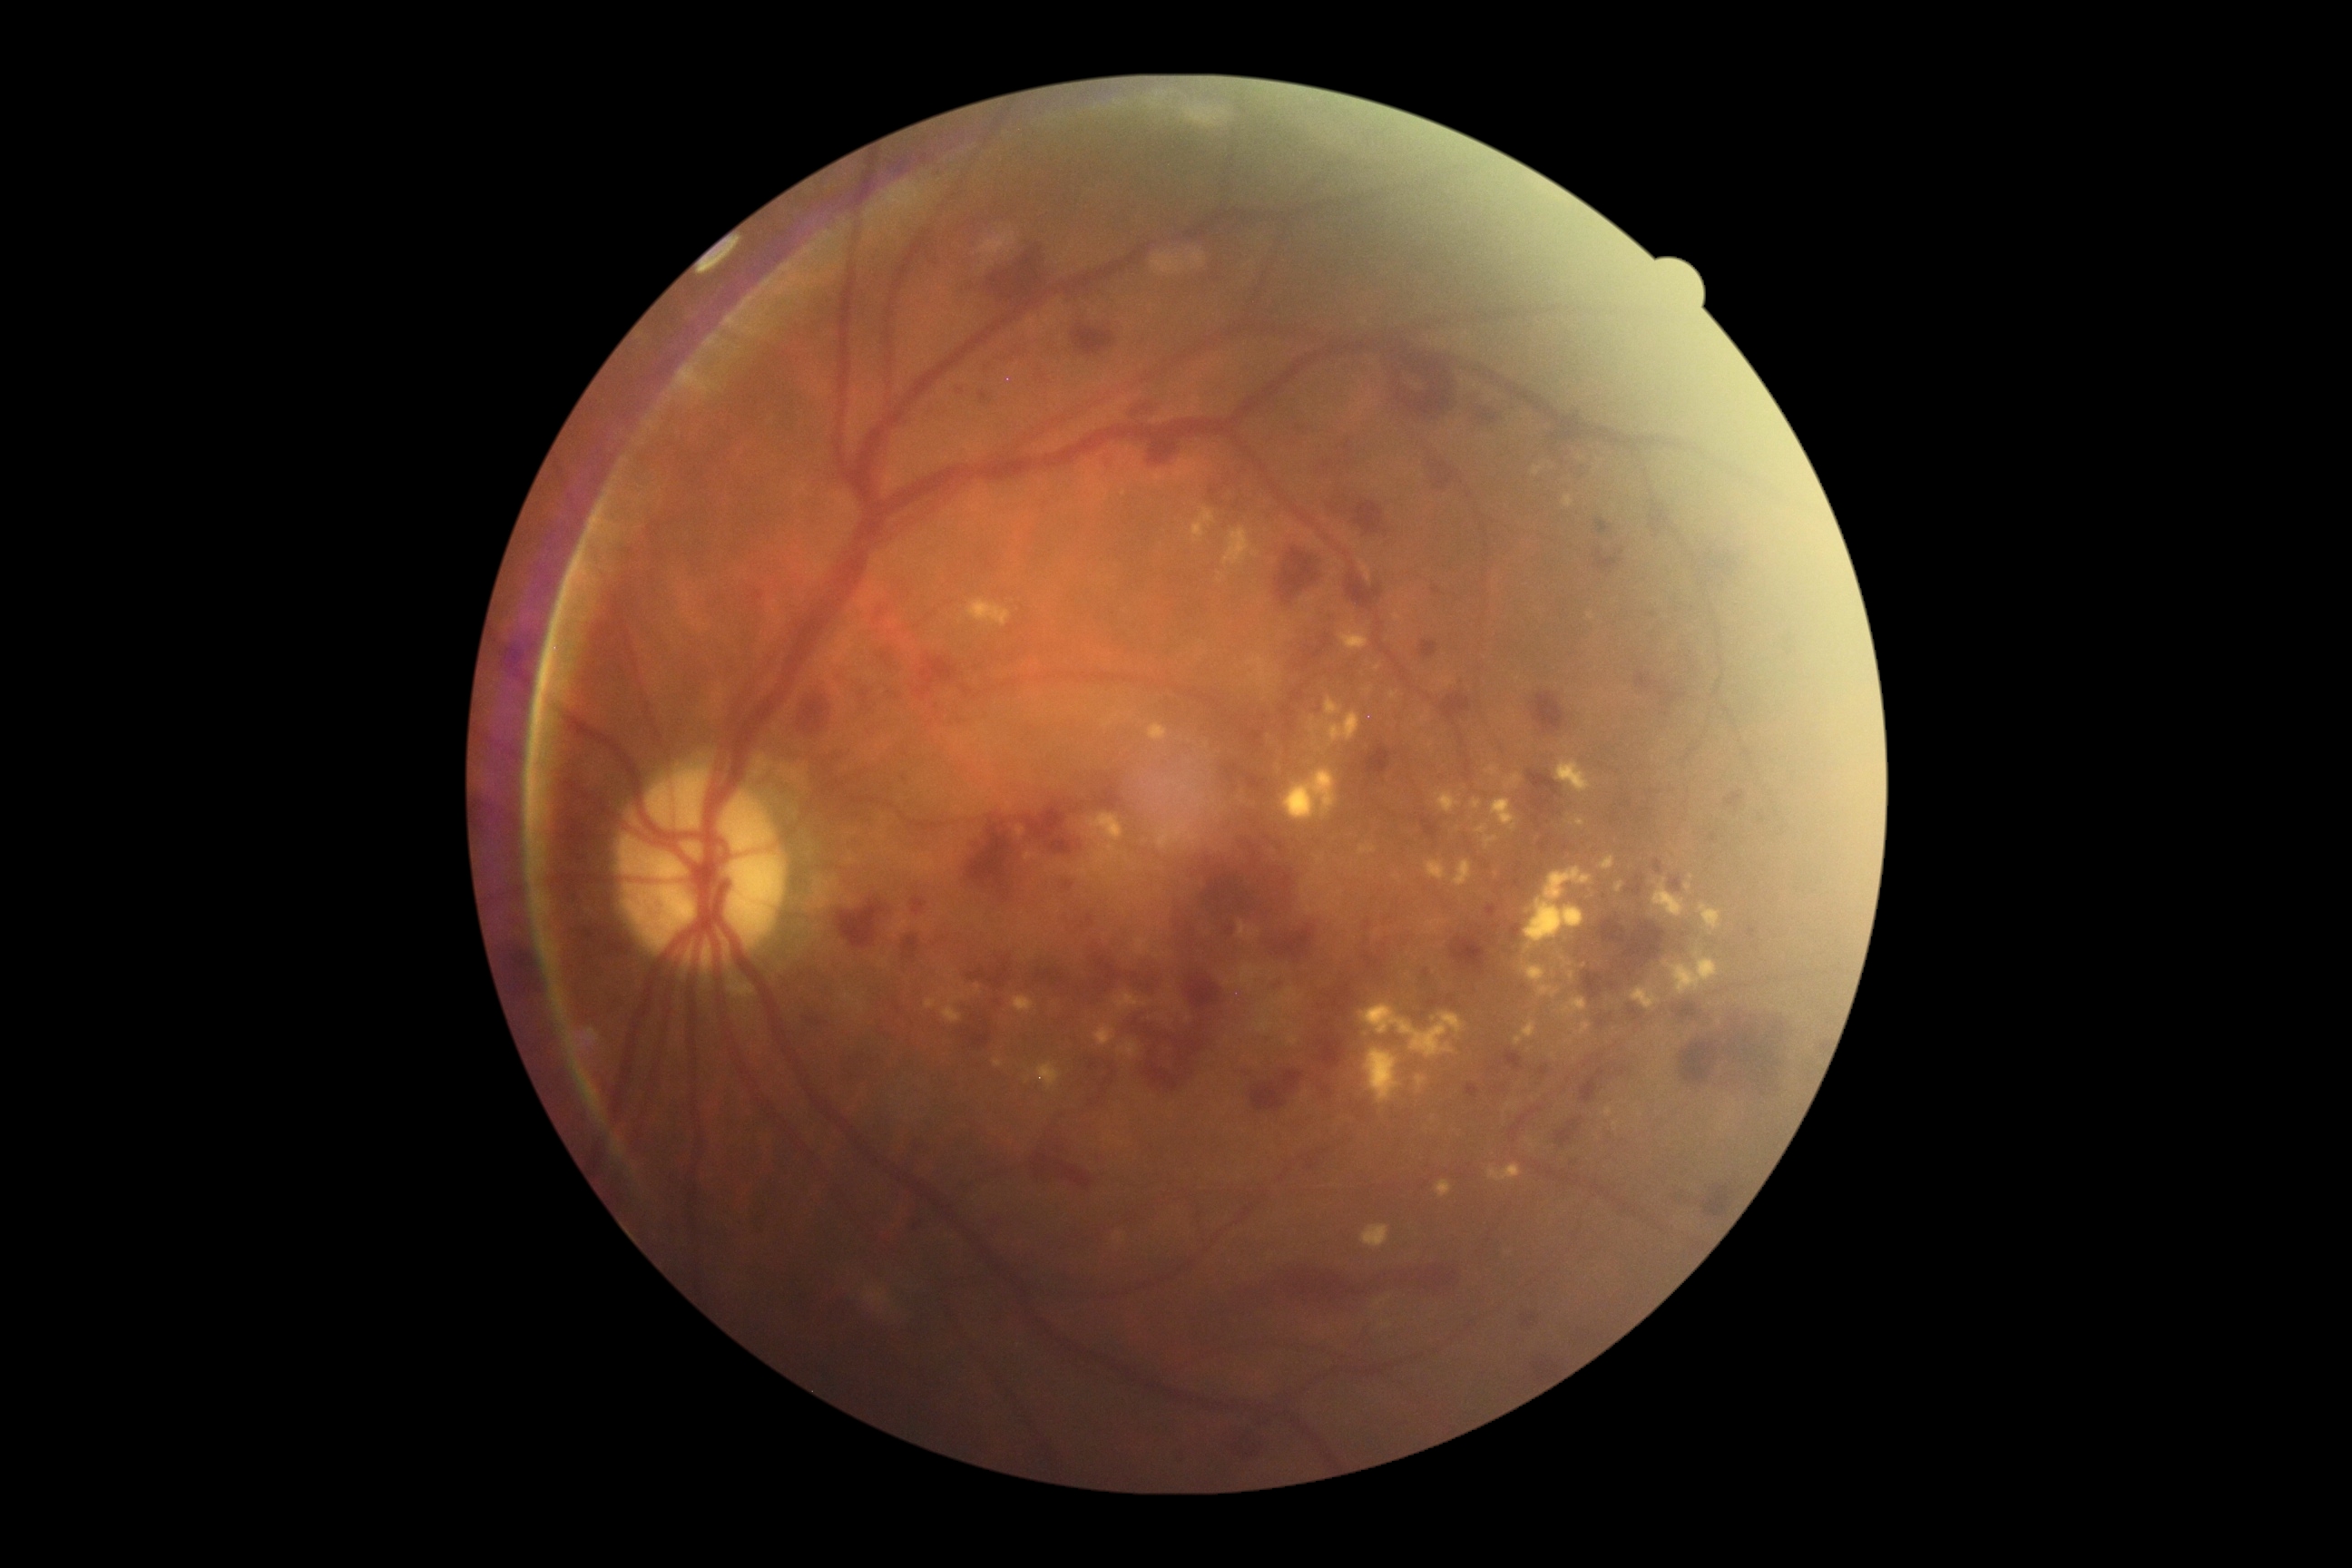 diabetic retinopathy (DR) = grade 3.